Modified Davis classification
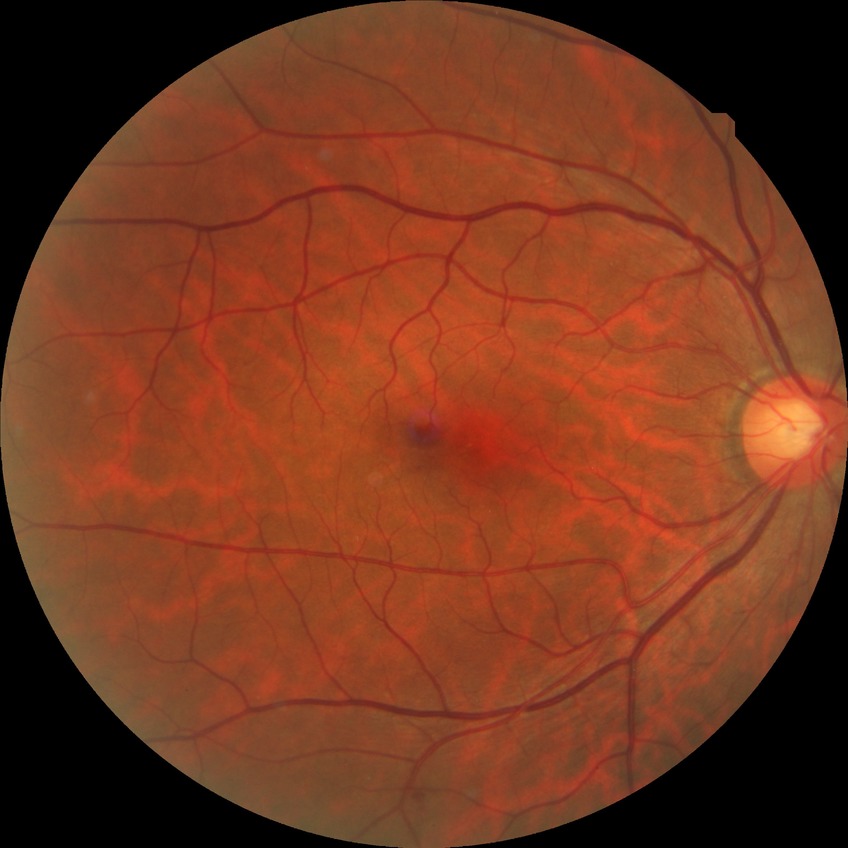
diabetic retinopathy (DR): NDR (no diabetic retinopathy)